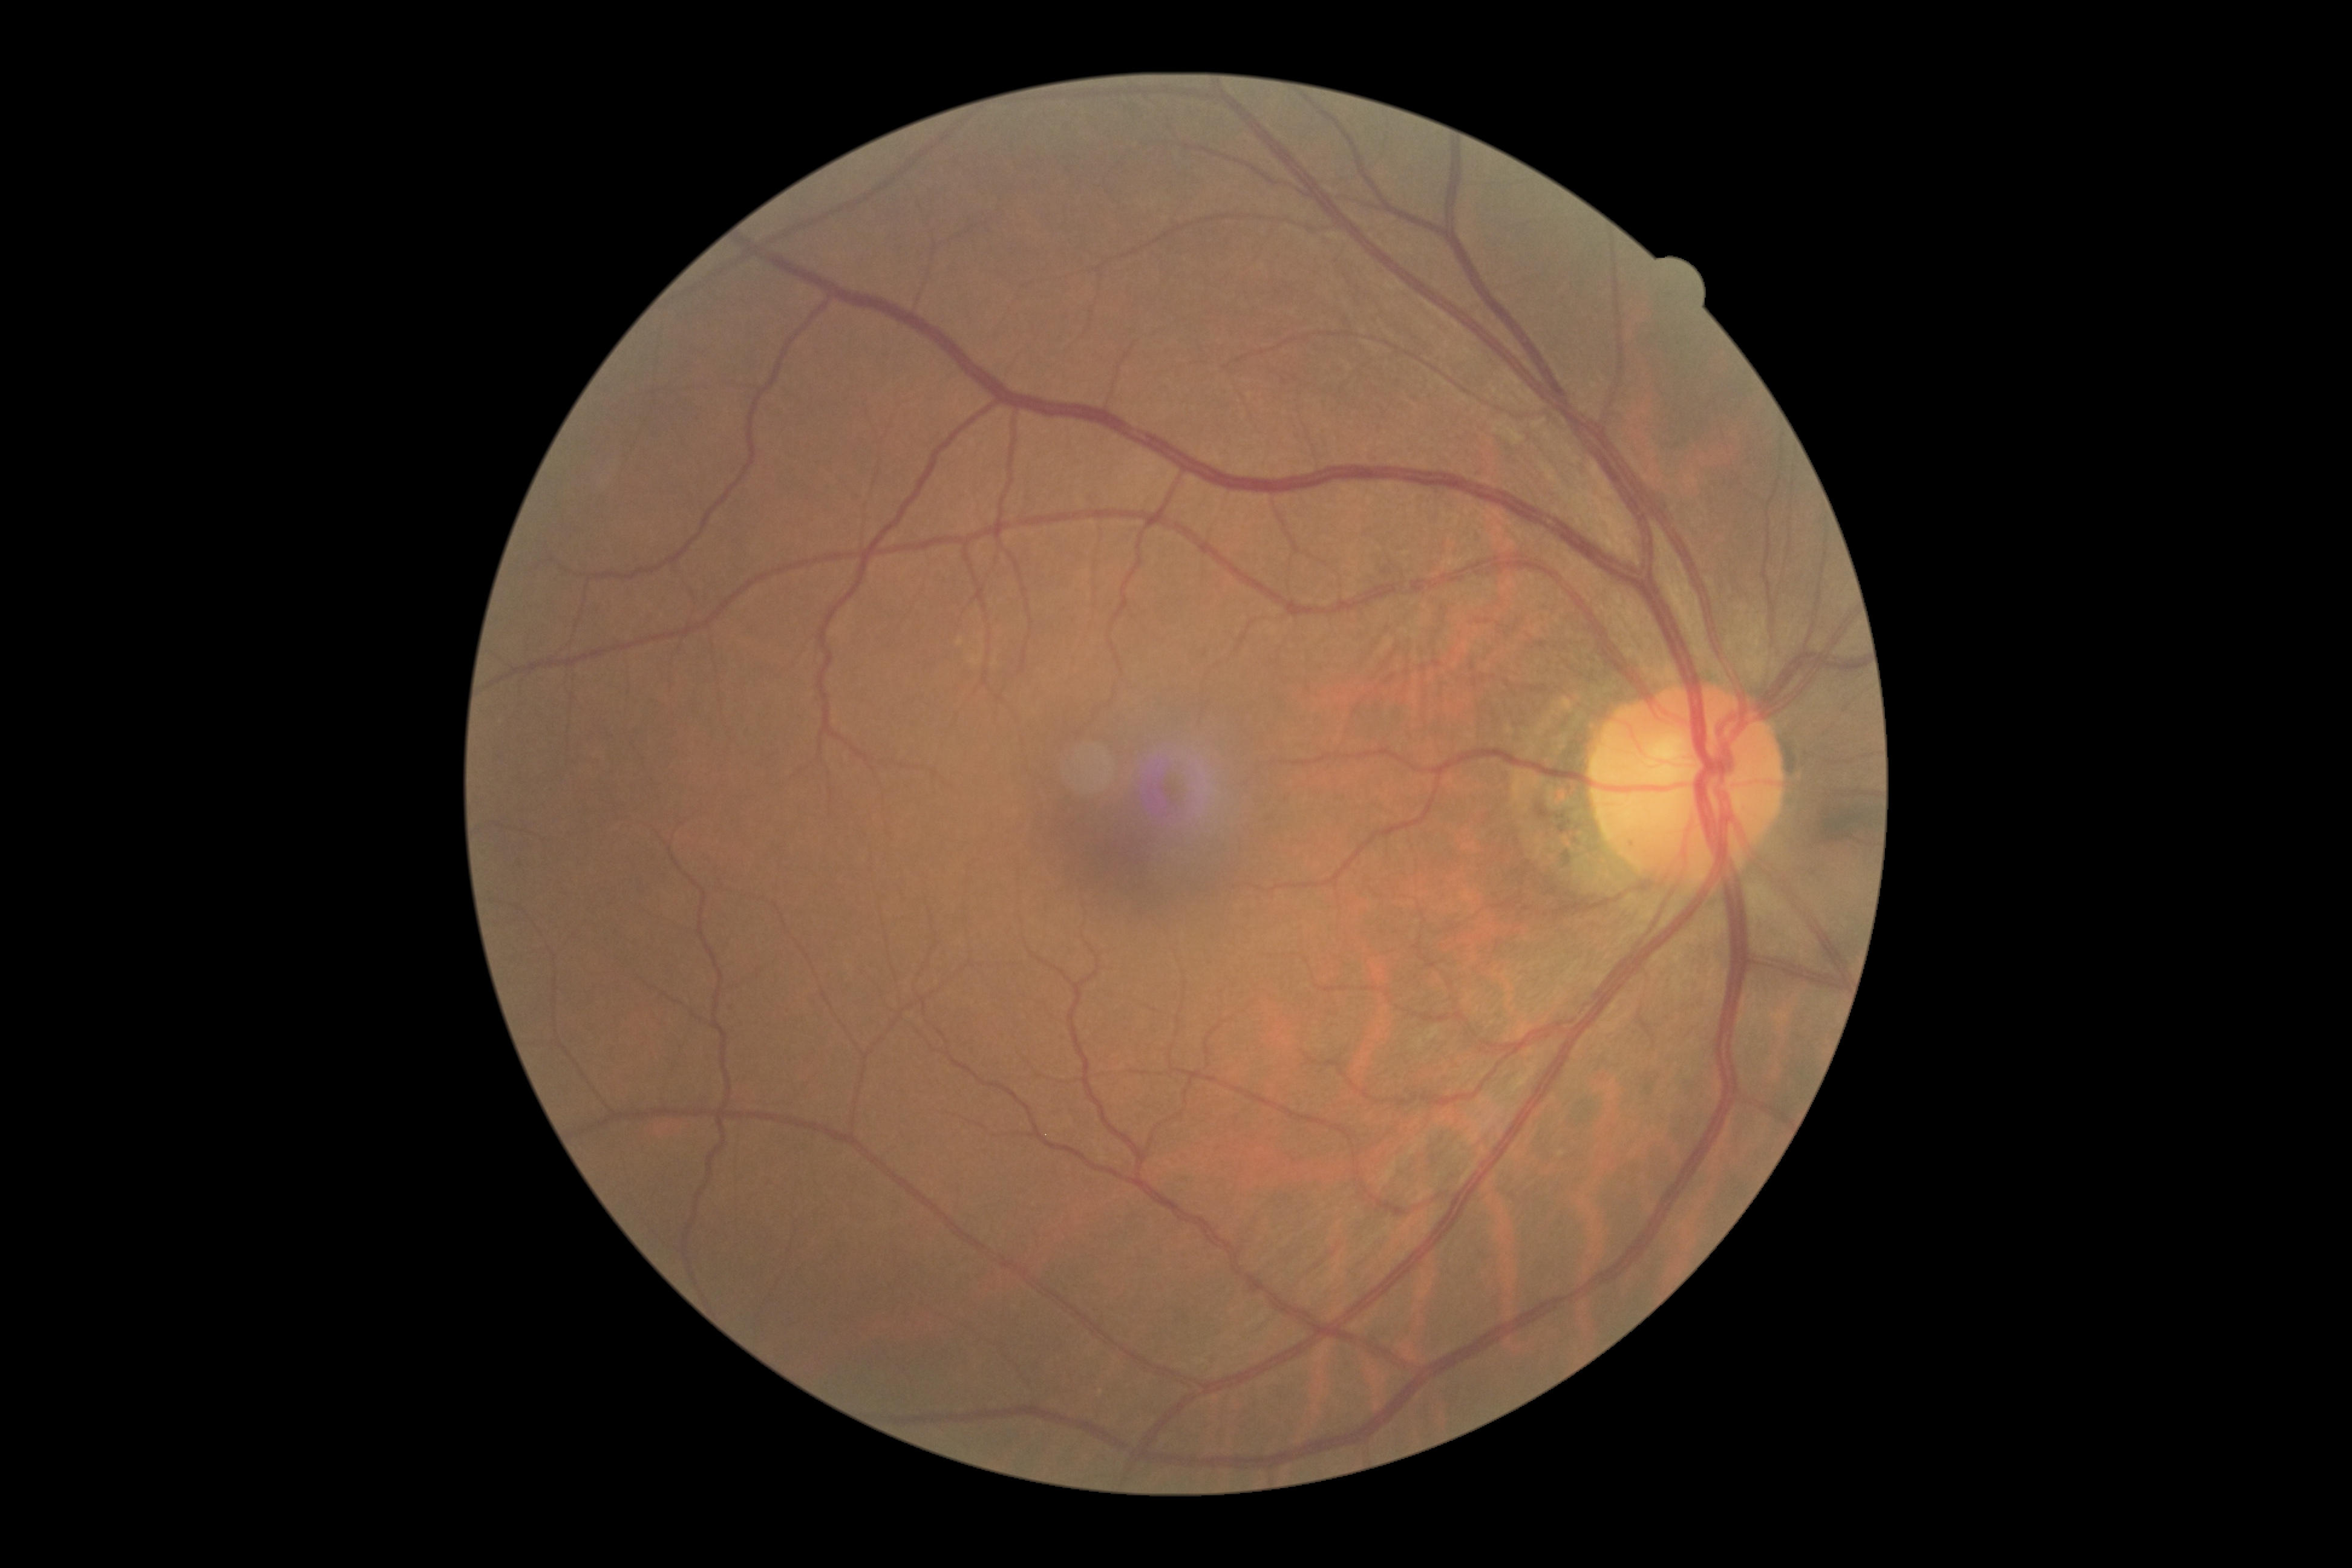 DR severity: no apparent diabetic retinopathy (grade 0).